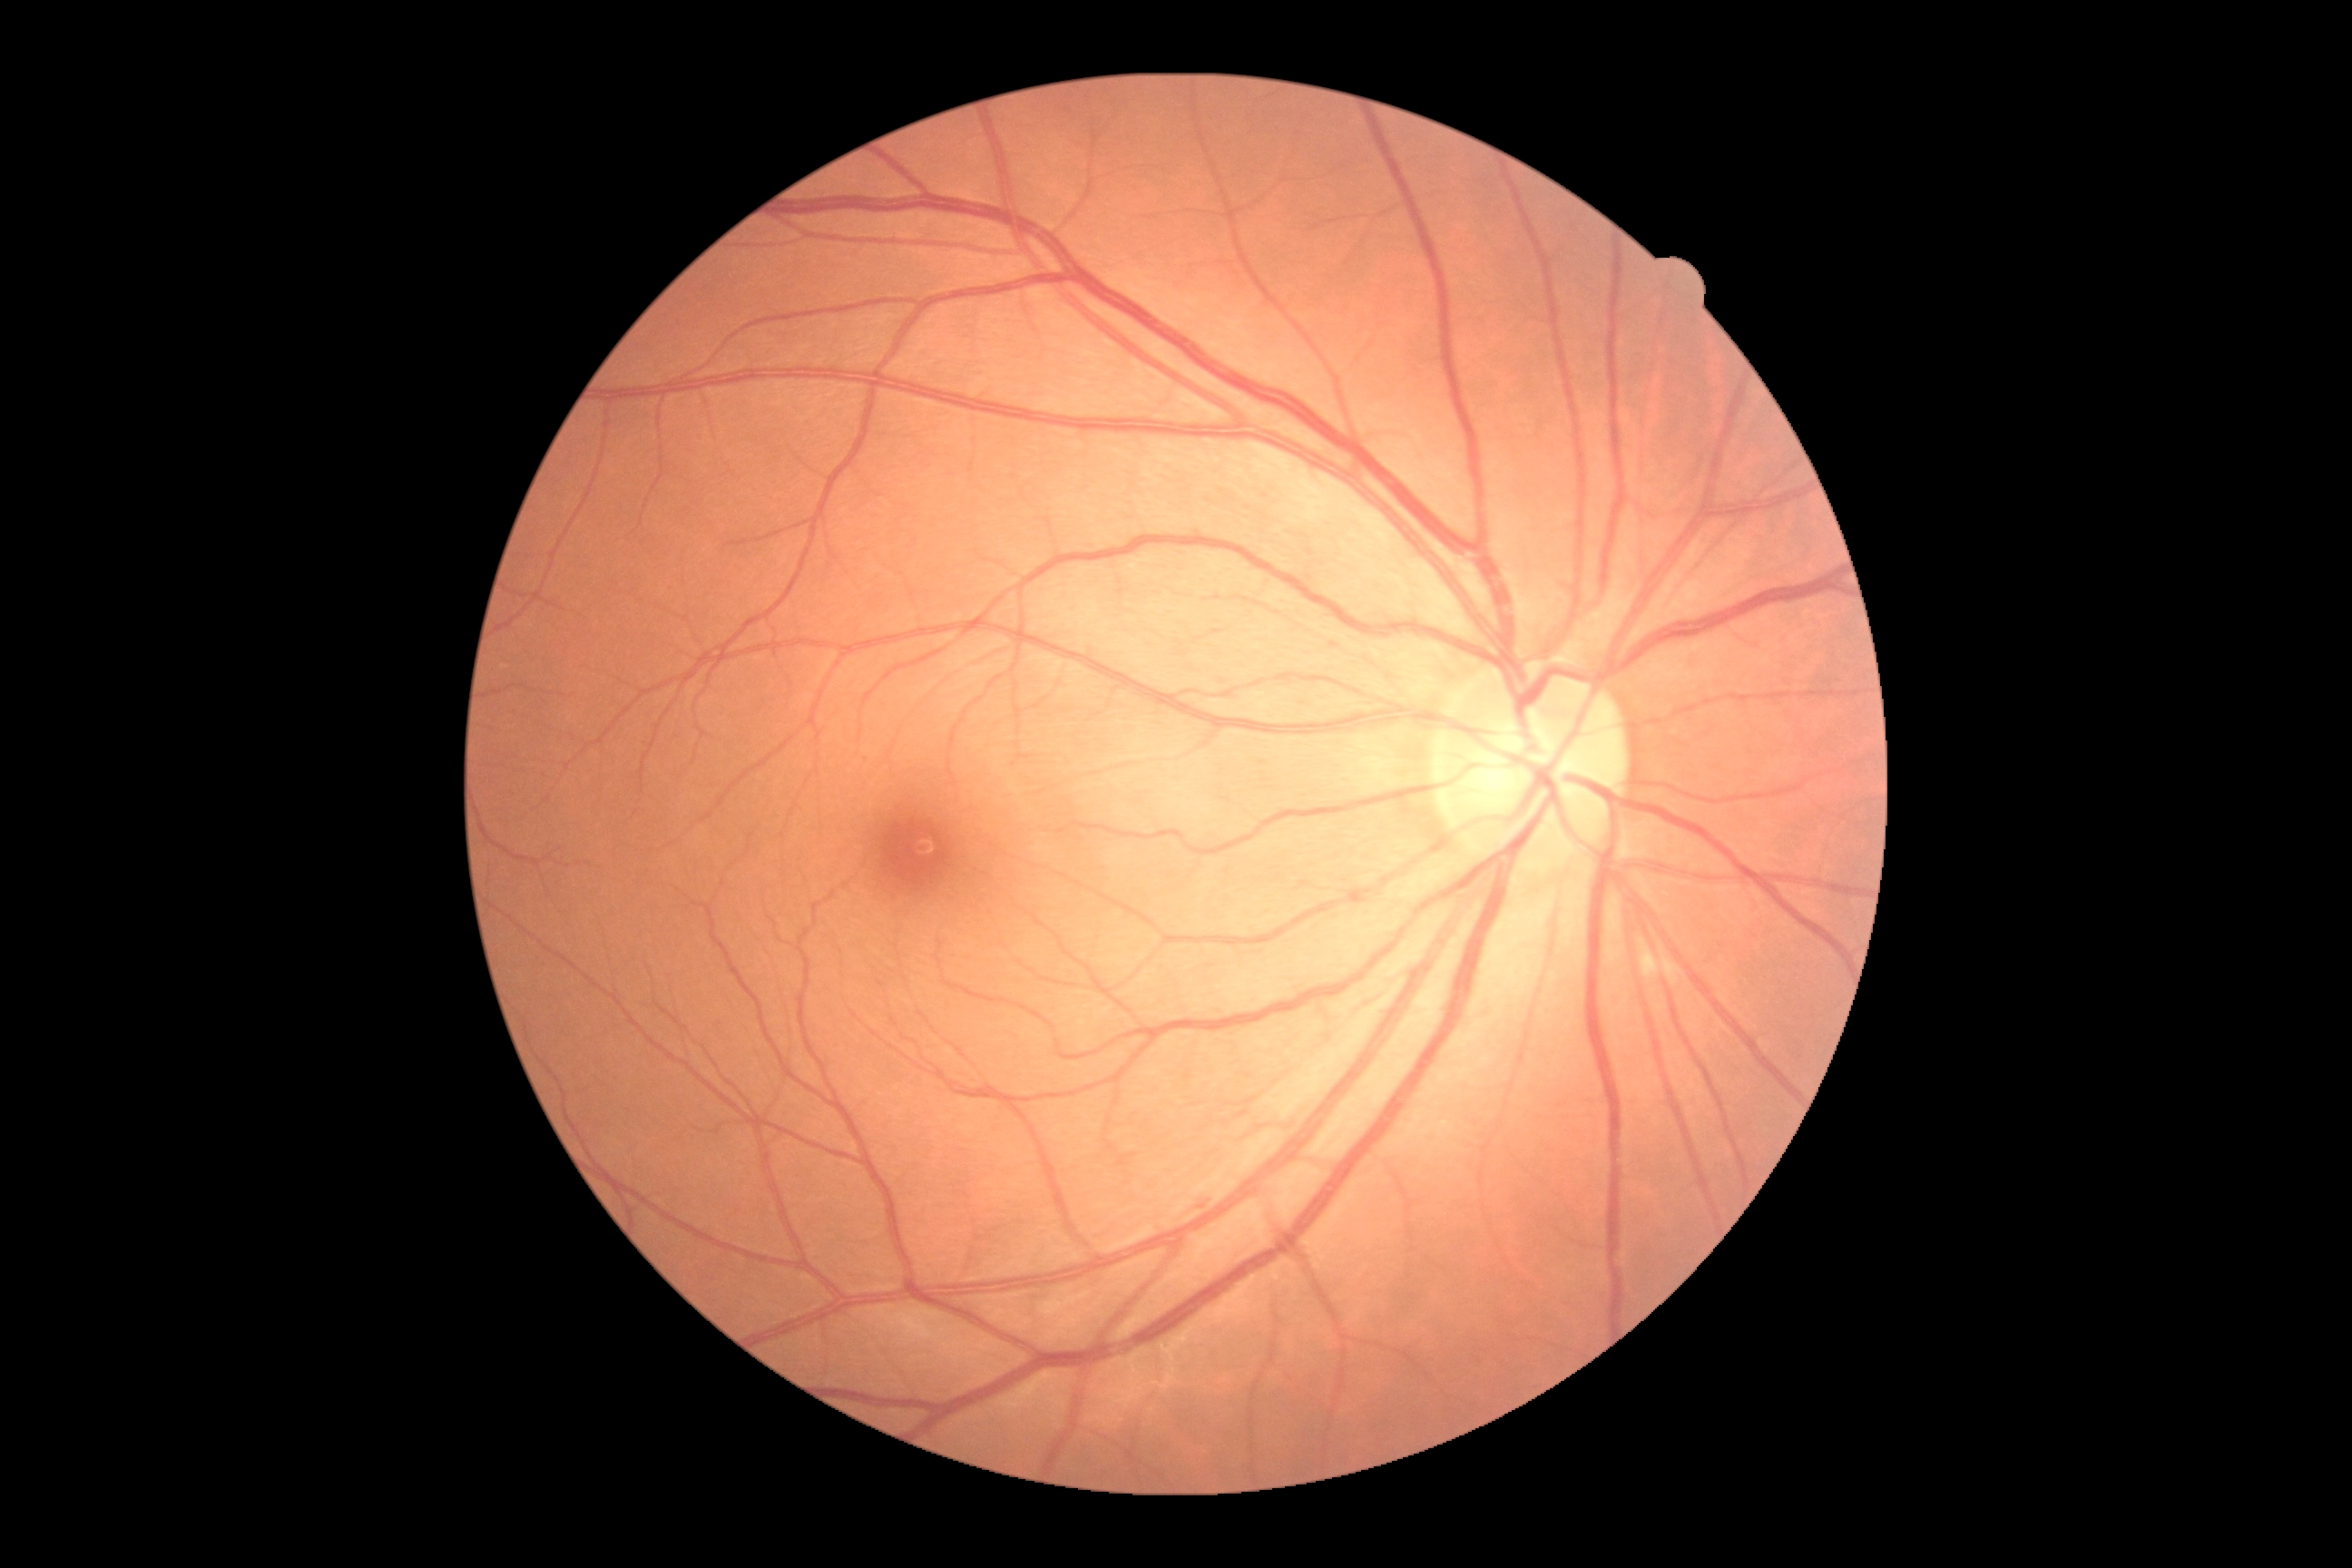 Diabetic retinopathy: grade 2 — more than just microaneurysms but less than severe NPDR.